Color fundus image
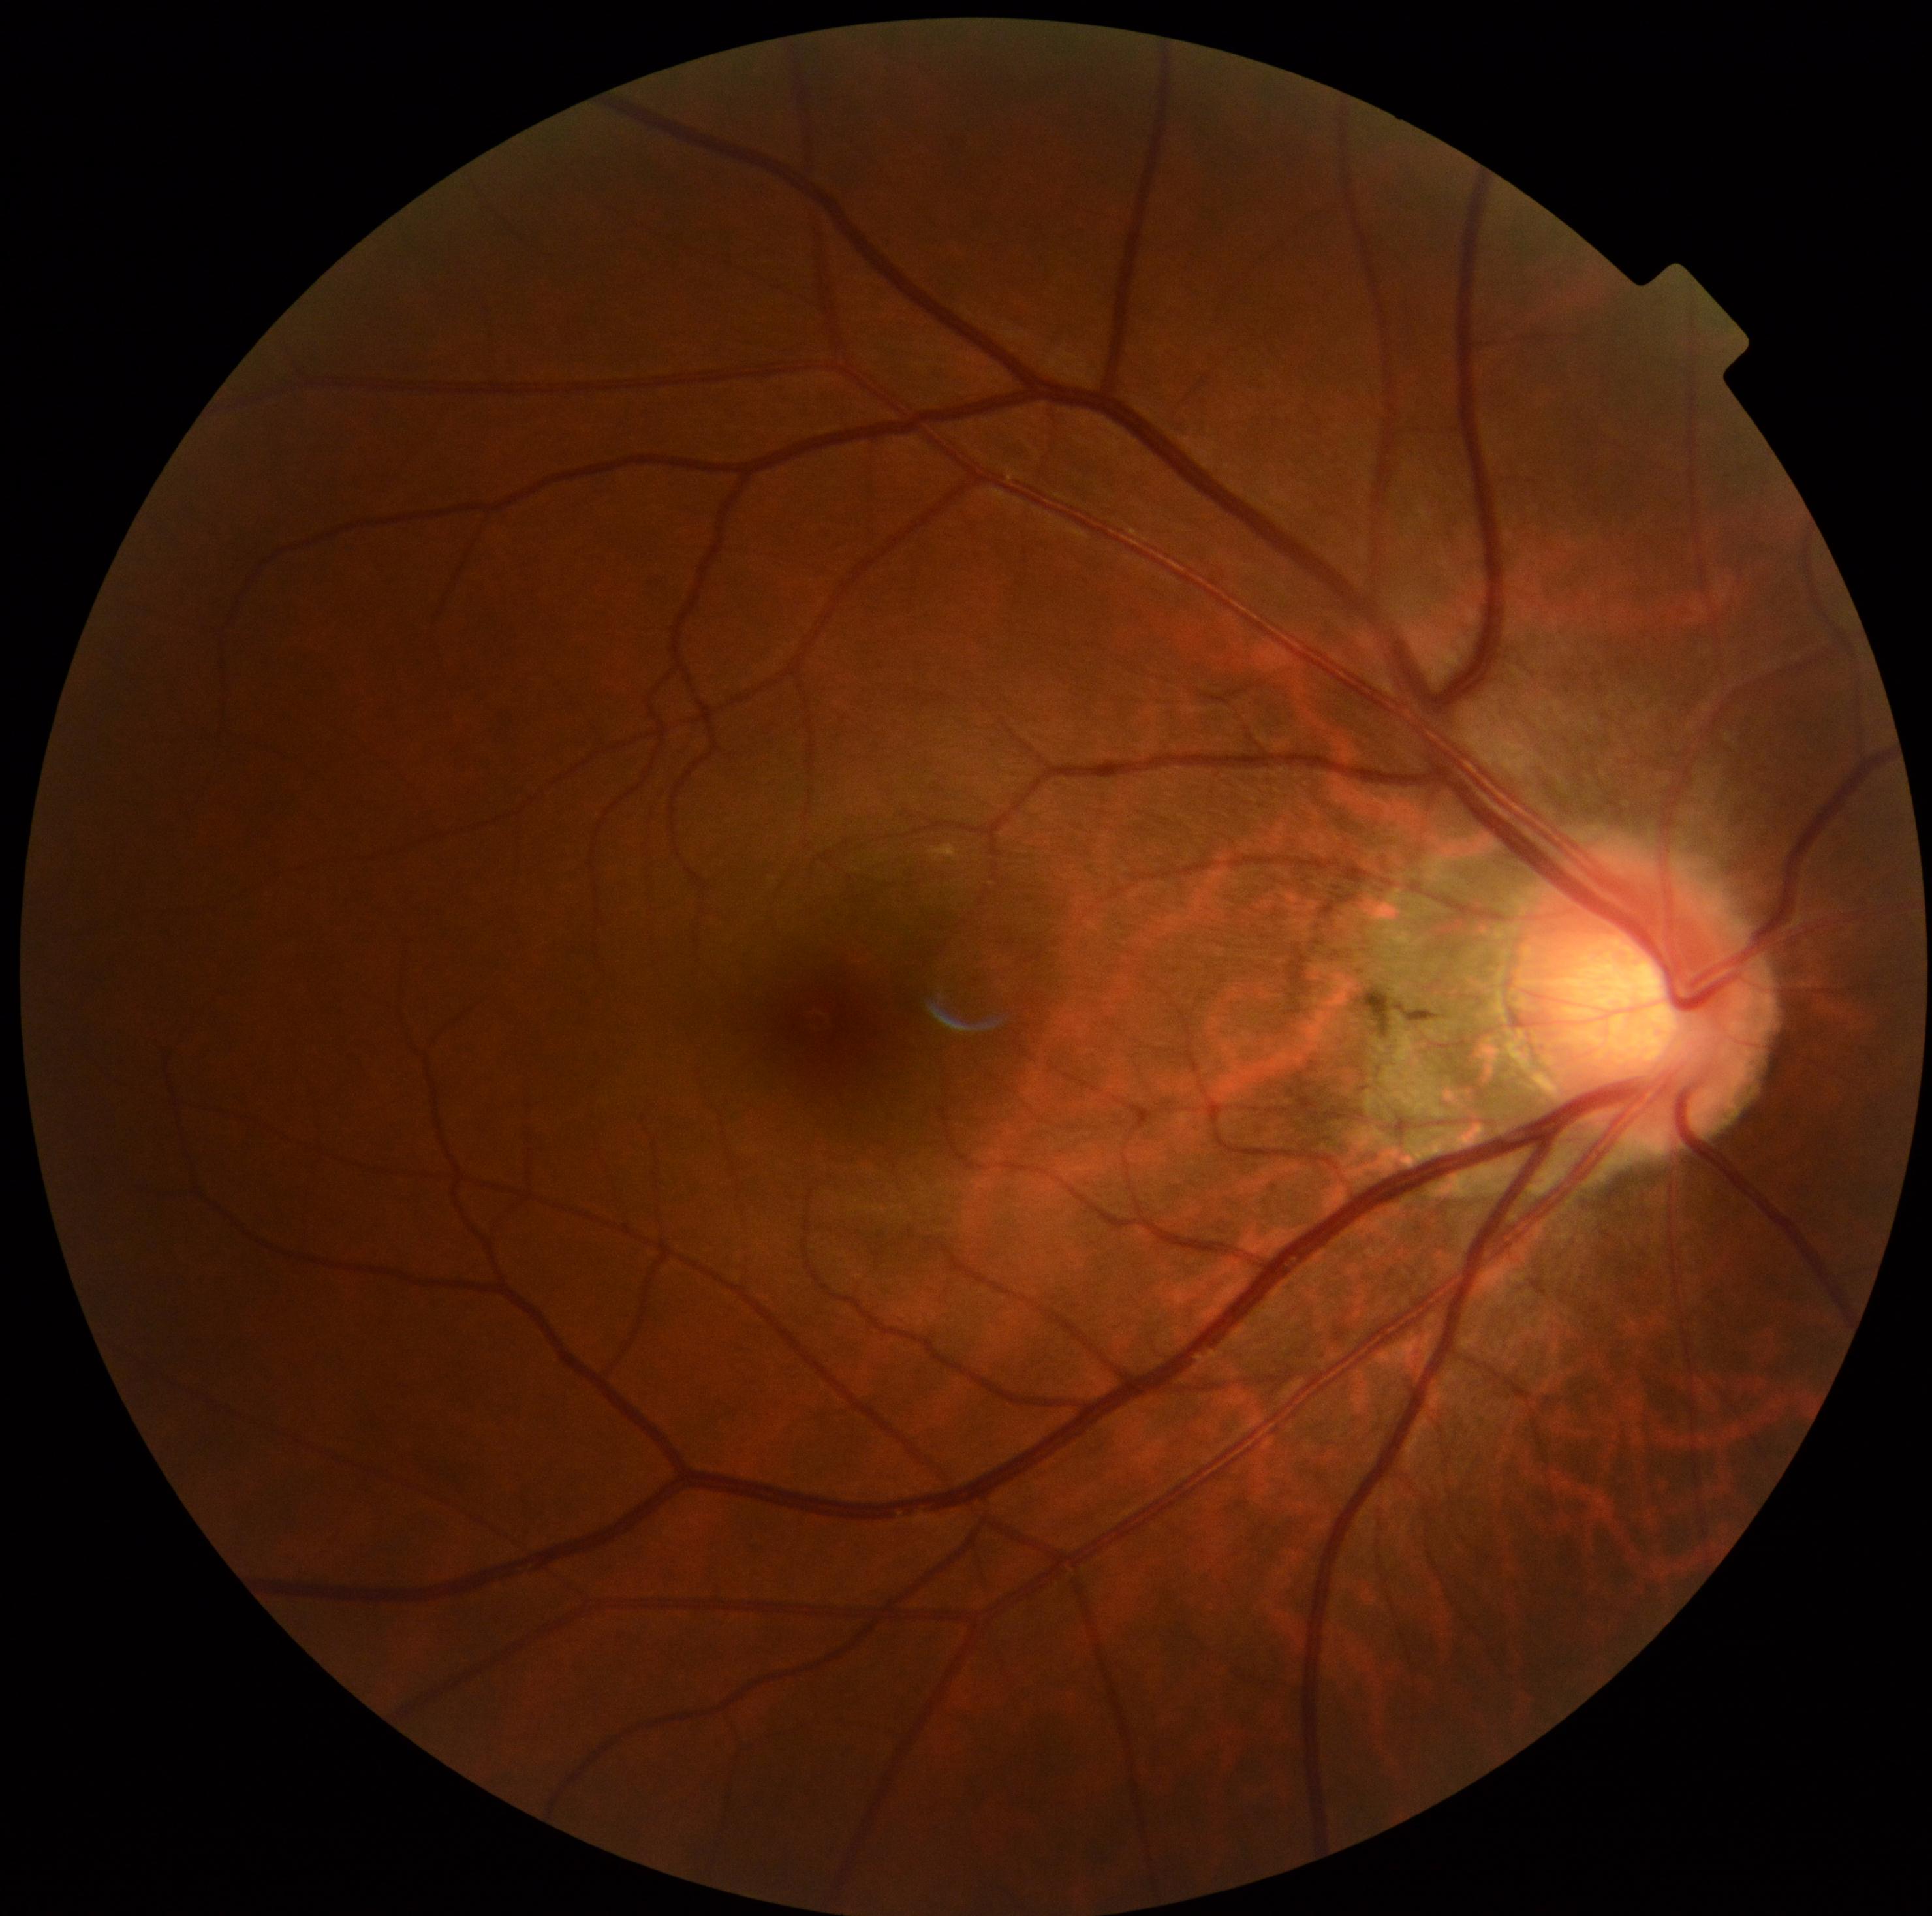

Diabetic retinopathy grade is 0 — no visible signs of diabetic retinopathy.